Color fundus photograph: 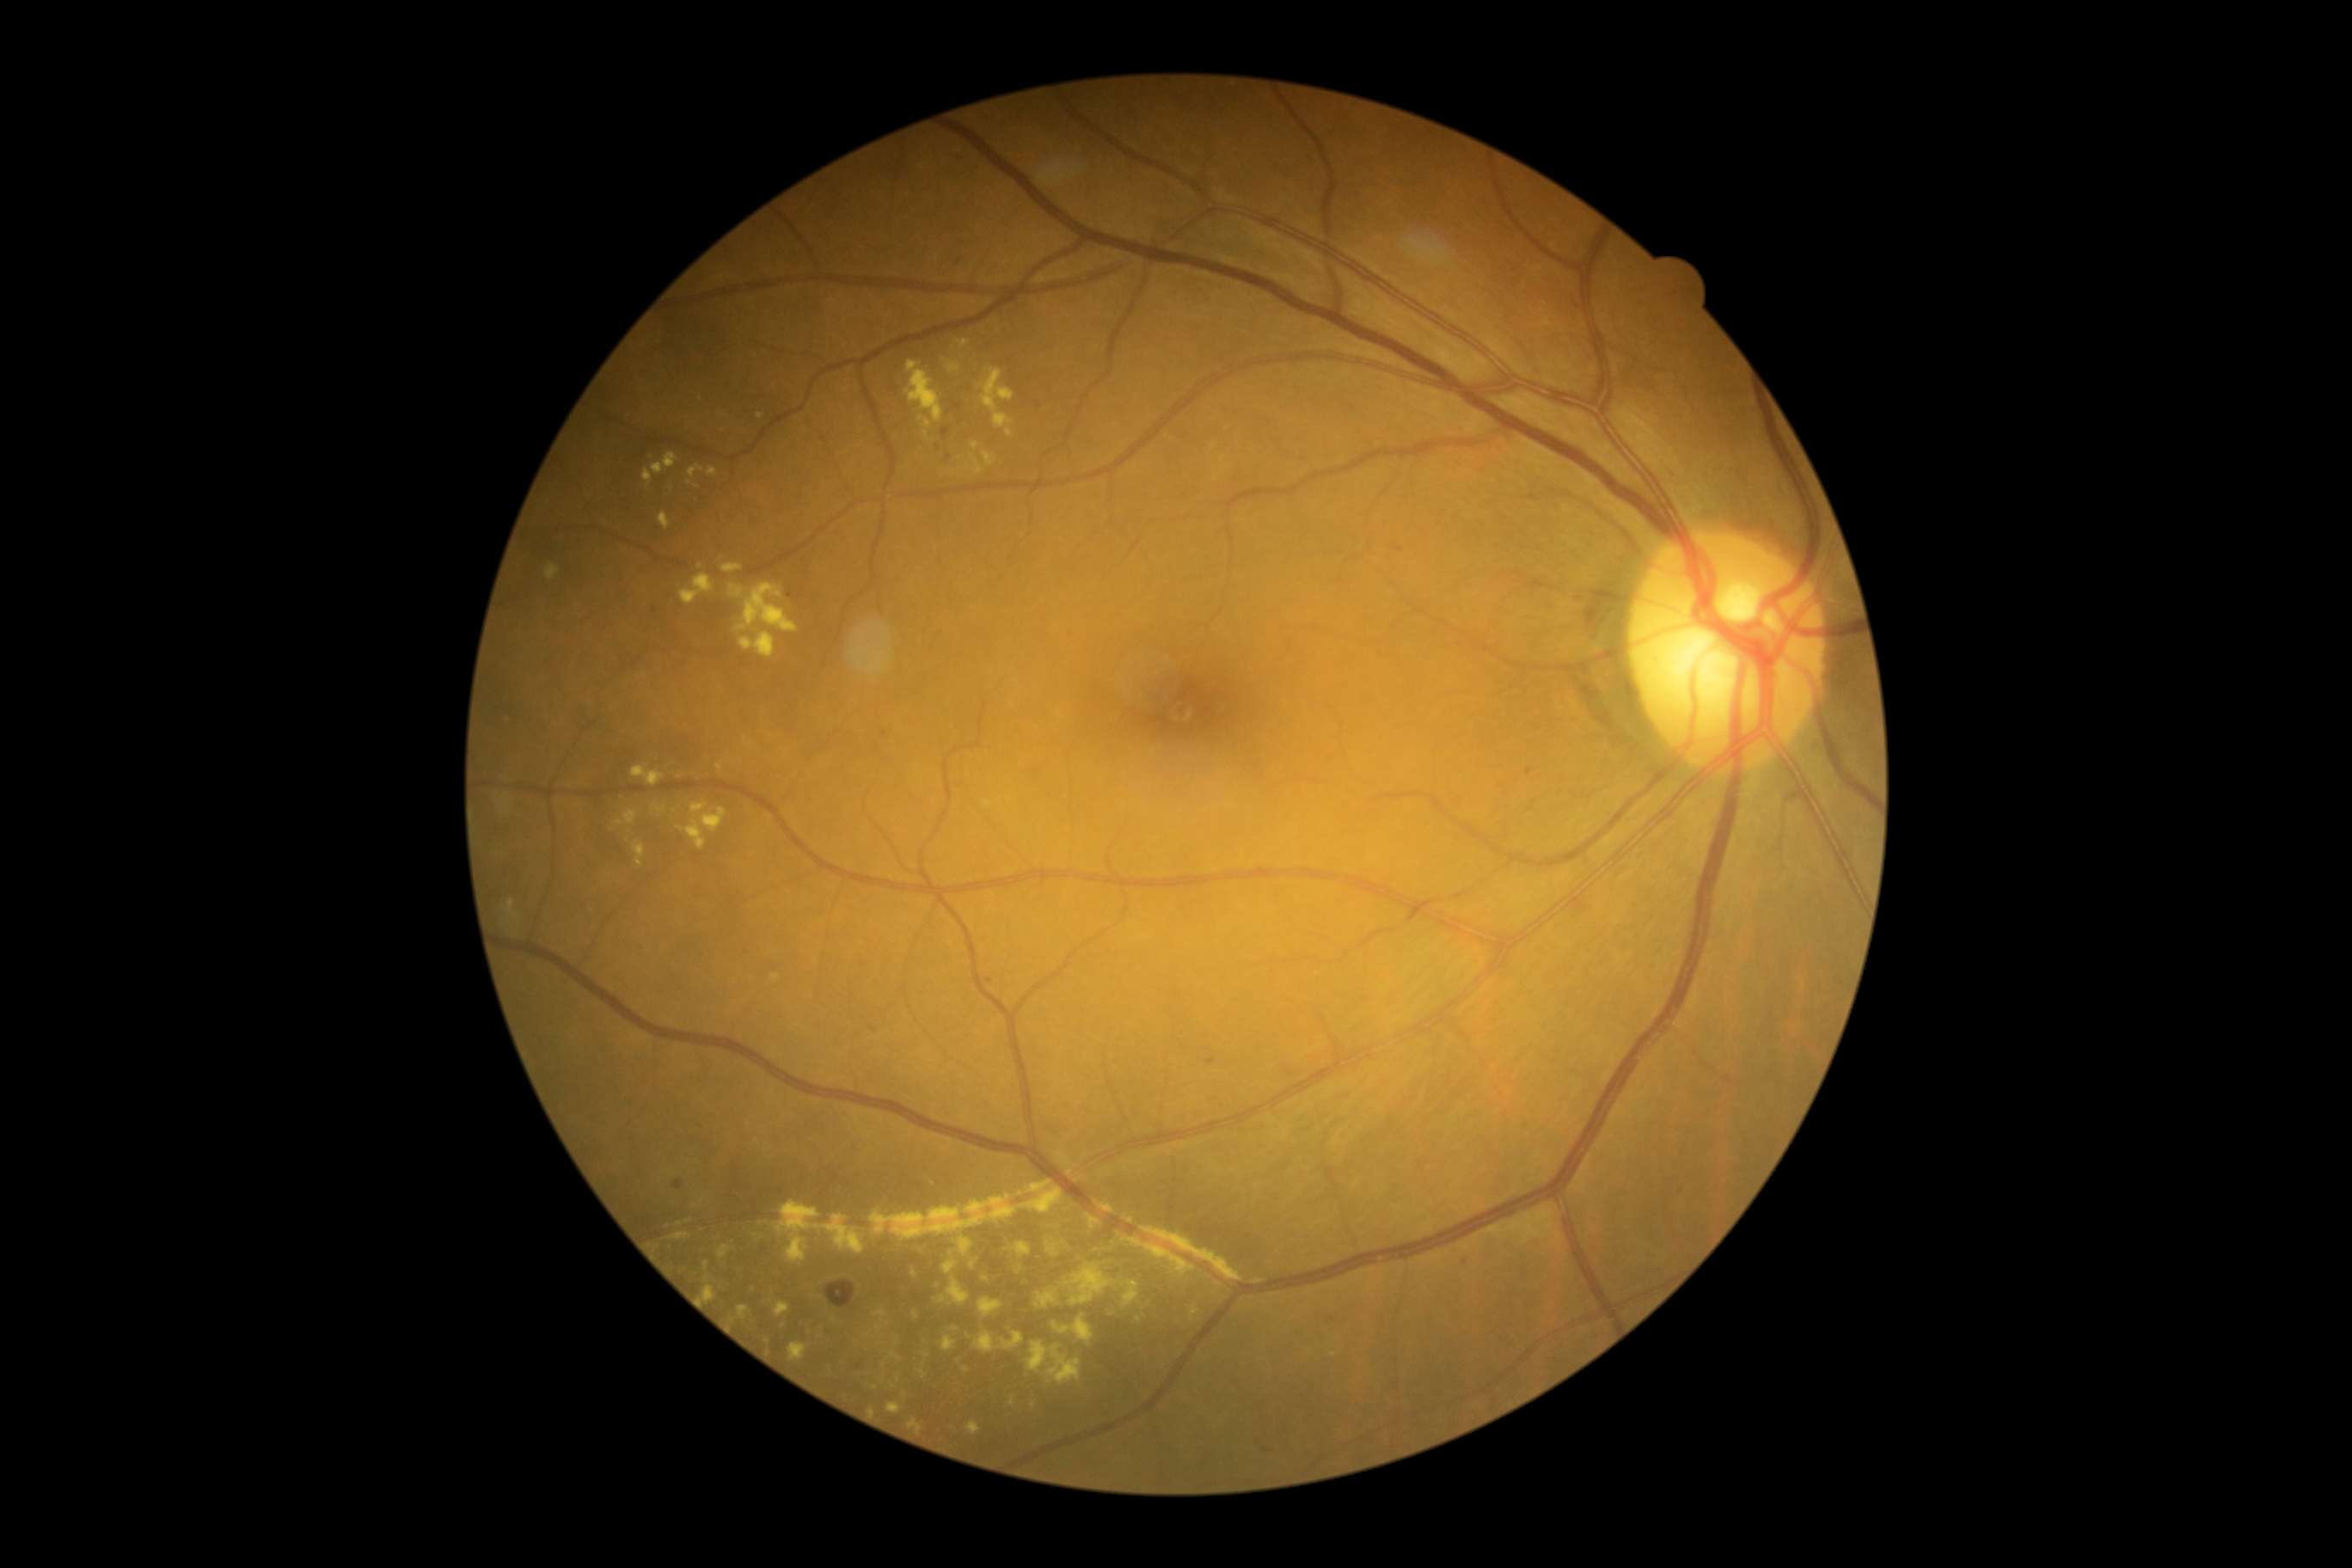 Retinopathy: 2
A subset of detected lesions:
hard exudates (subset): bbox(707, 467, 718, 477) | bbox(702, 1285, 718, 1302) | bbox(546, 563, 560, 580) | bbox(934, 1297, 946, 1304) | bbox(615, 819, 623, 826) | bbox(909, 1419, 924, 1433) | bbox(1125, 1216, 1134, 1223) | bbox(814, 1295, 823, 1299) | bbox(735, 584, 800, 634) | bbox(652, 453, 678, 475) | bbox(888, 1402, 902, 1414) | bbox(788, 1342, 807, 1361) | bbox(1051, 1314, 1094, 1344)
Small hard exudates approximately at <point>966, 1369</point> | <point>898, 1379</point> | <point>746, 739</point> | <point>1127, 1164</point> | <point>1228, 429</point> | <point>697, 487</point>